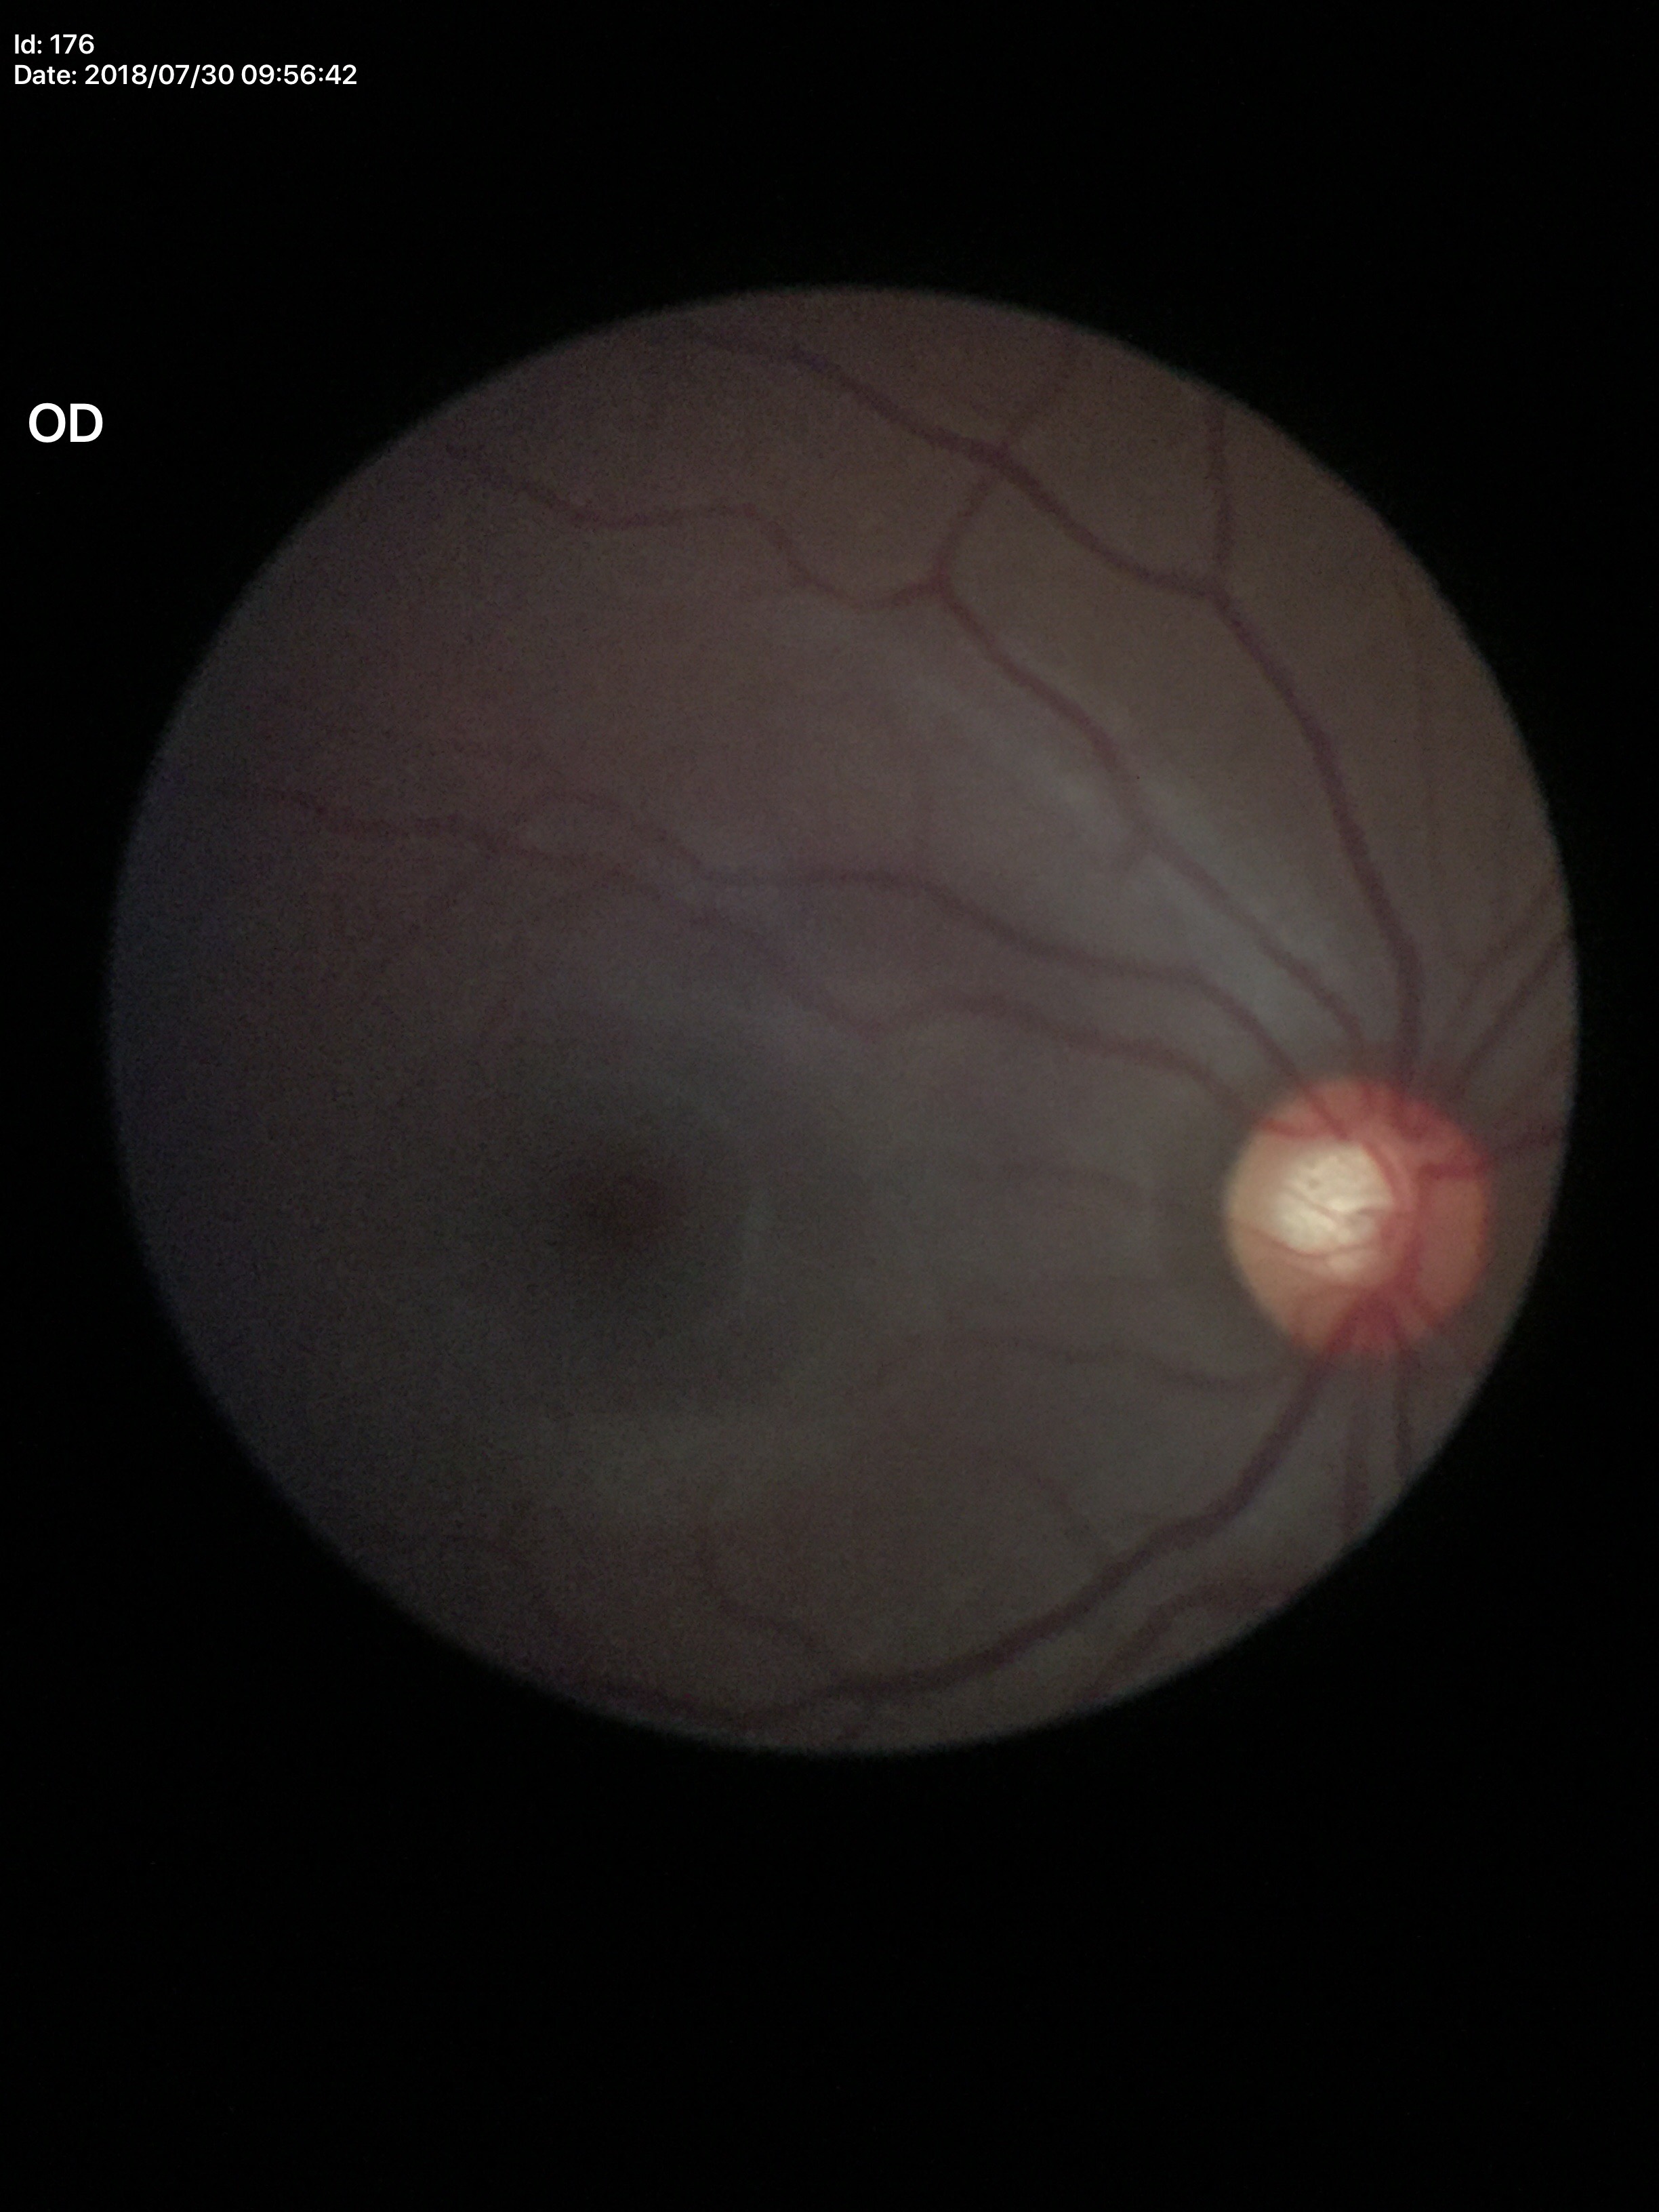

Glaucoma impression: negative (1/5 graders called glaucoma suspect) | horizontal cup-disc ratio: 0.62 | vertical C/D ratio: 0.58.